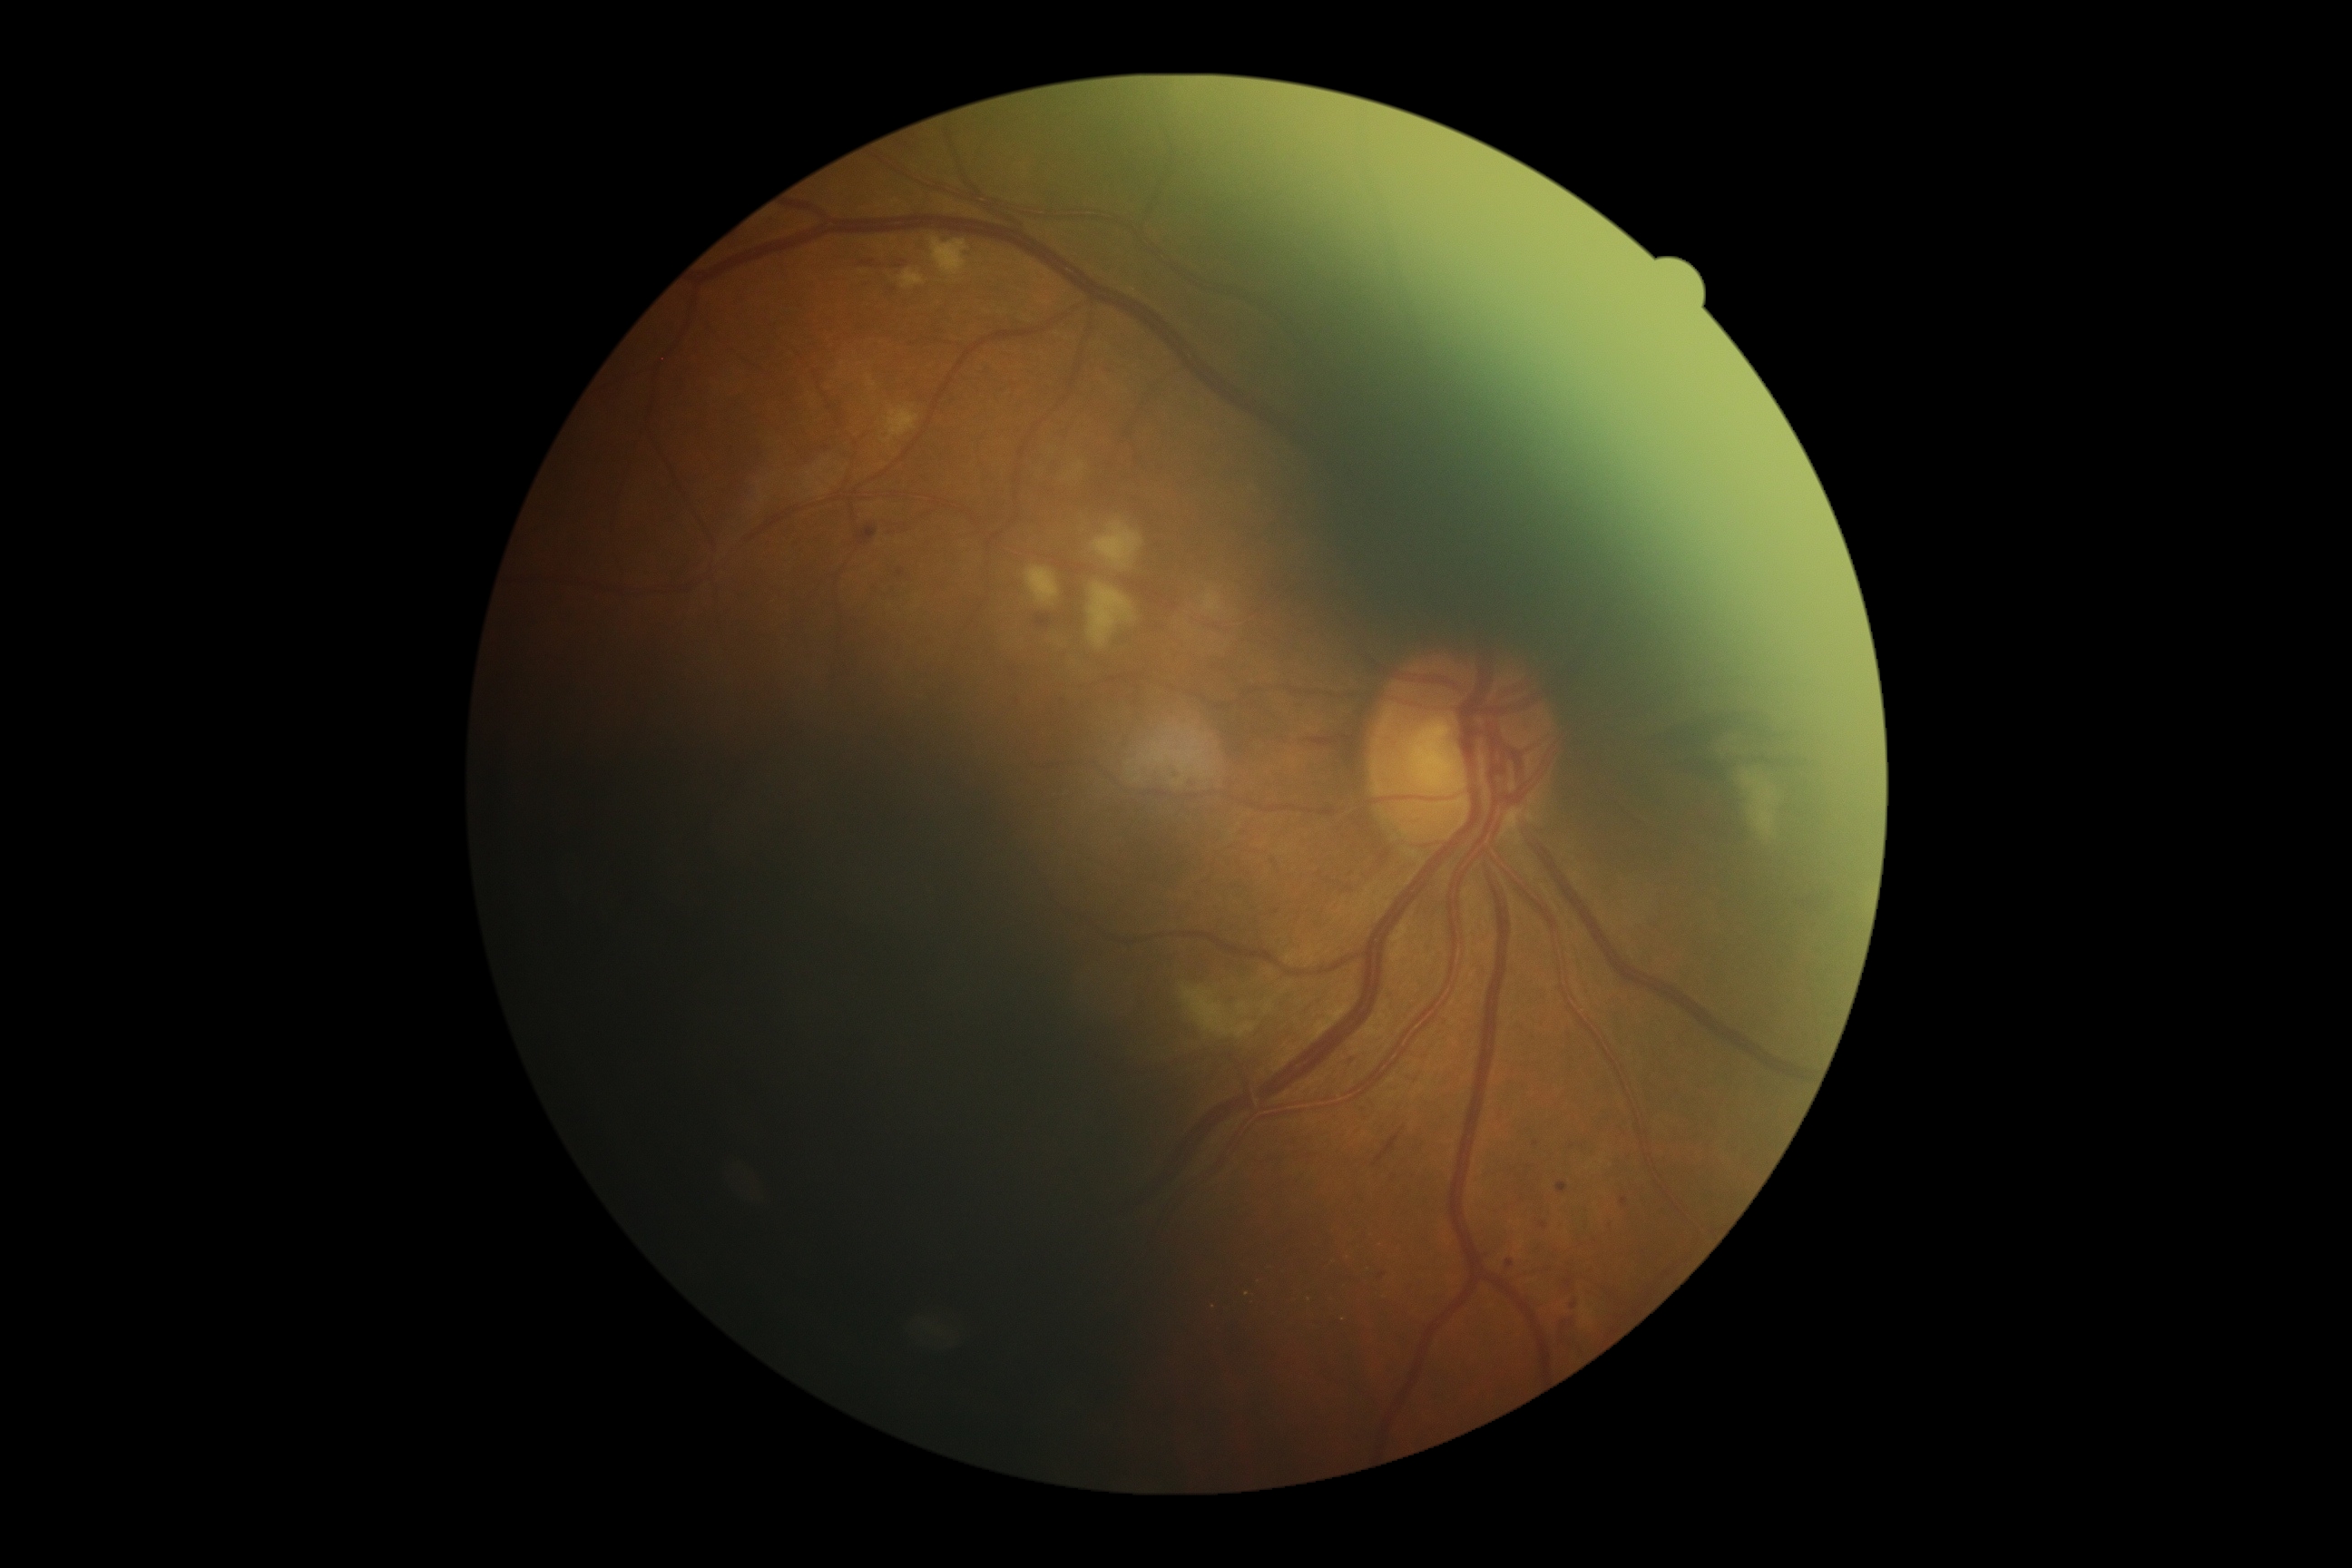

DR class: non-proliferative diabetic retinopathy. DR severity: grade 2 (moderate NPDR).